Fundus photo.
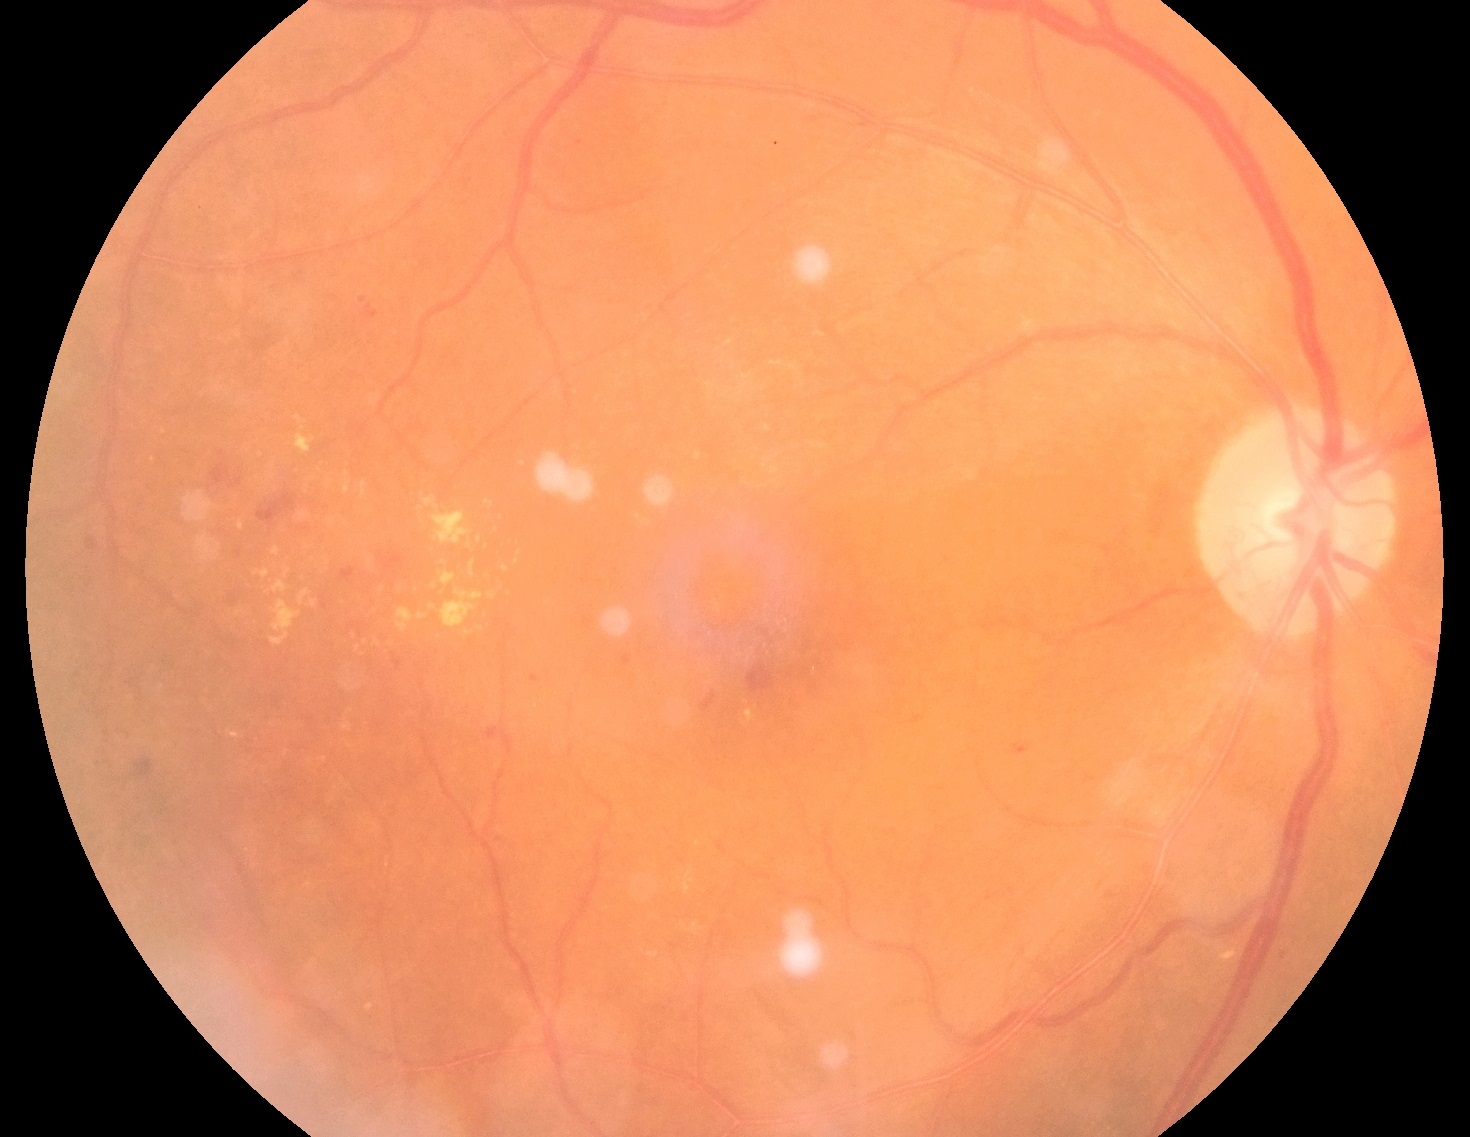 Diabetic retinopathy (DR): grade 2 (moderate NPDR).